848x848px — 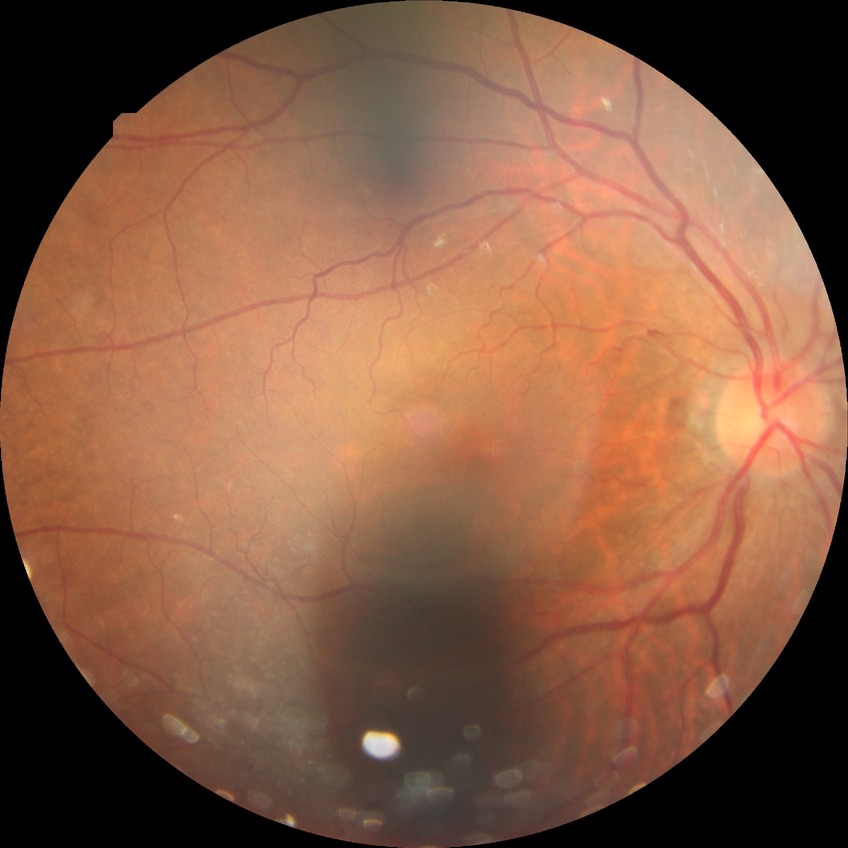
Diabetic retinopathy (DR) is no diabetic retinopathy (NDR).